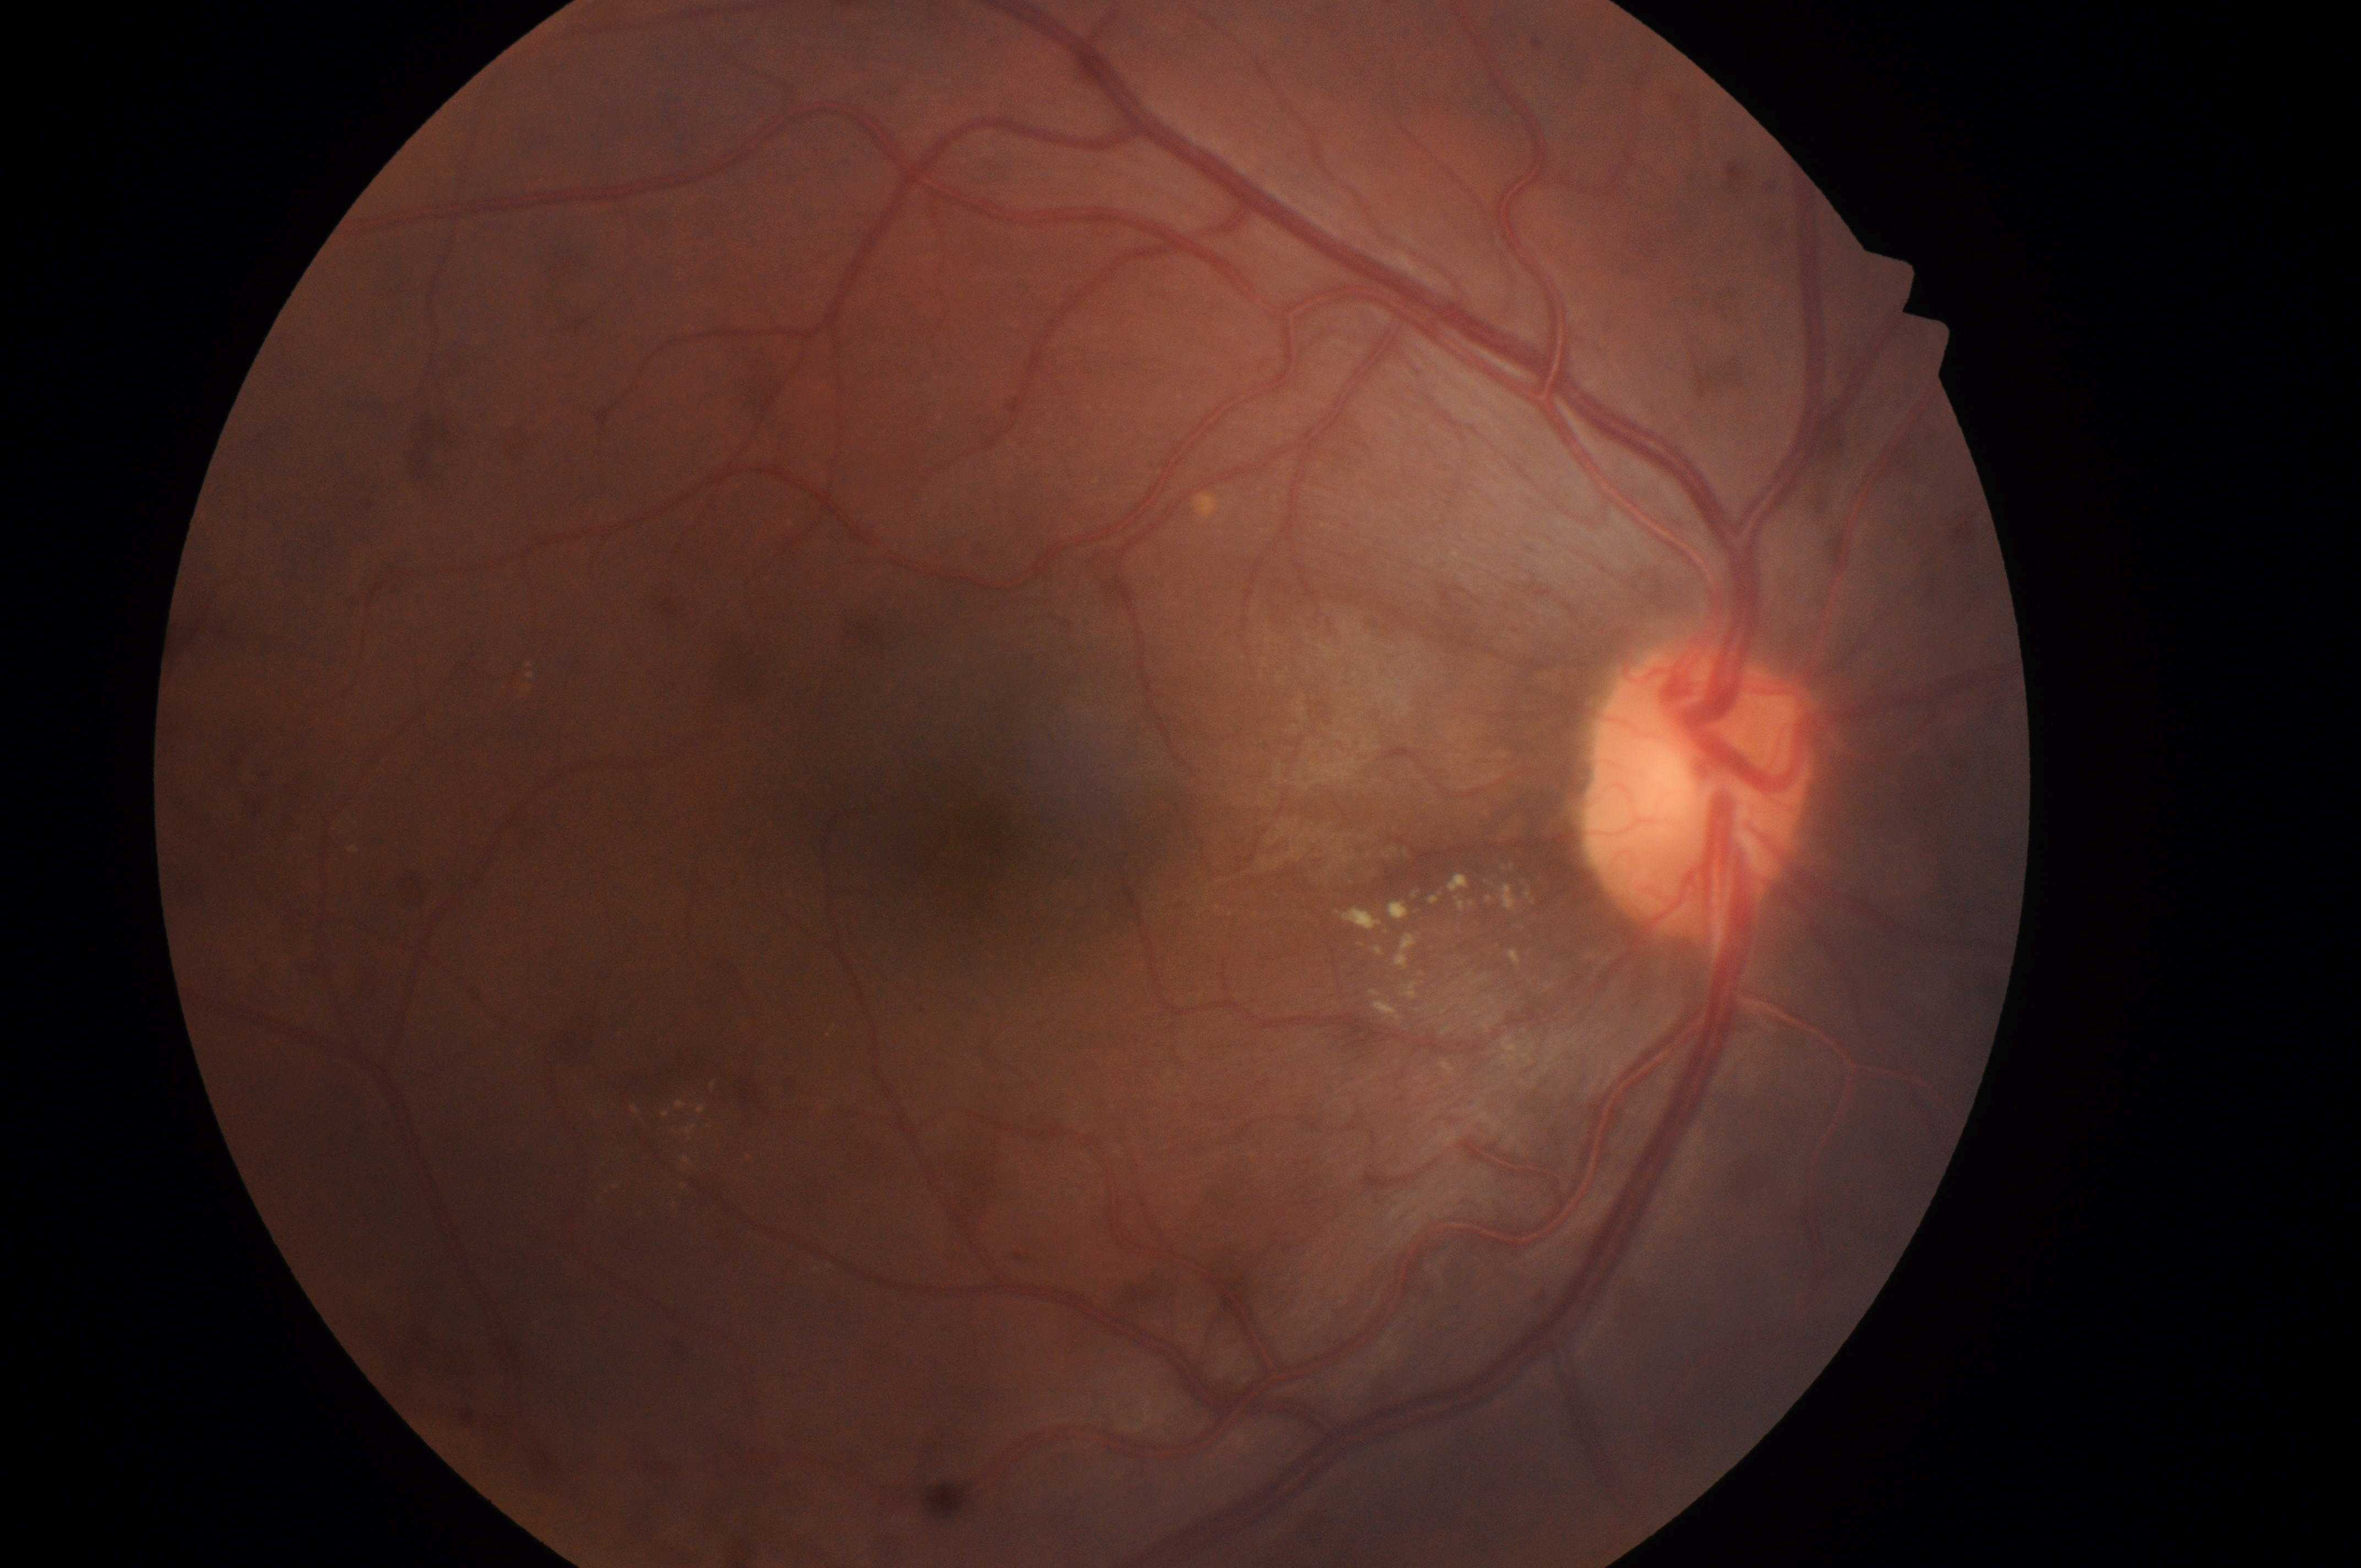 {"optic_disc": "1694px, 802px", "fovea": "996px, 806px", "dme_grade": "1", "eye": "right eye", "dr_grade": "2/4"}